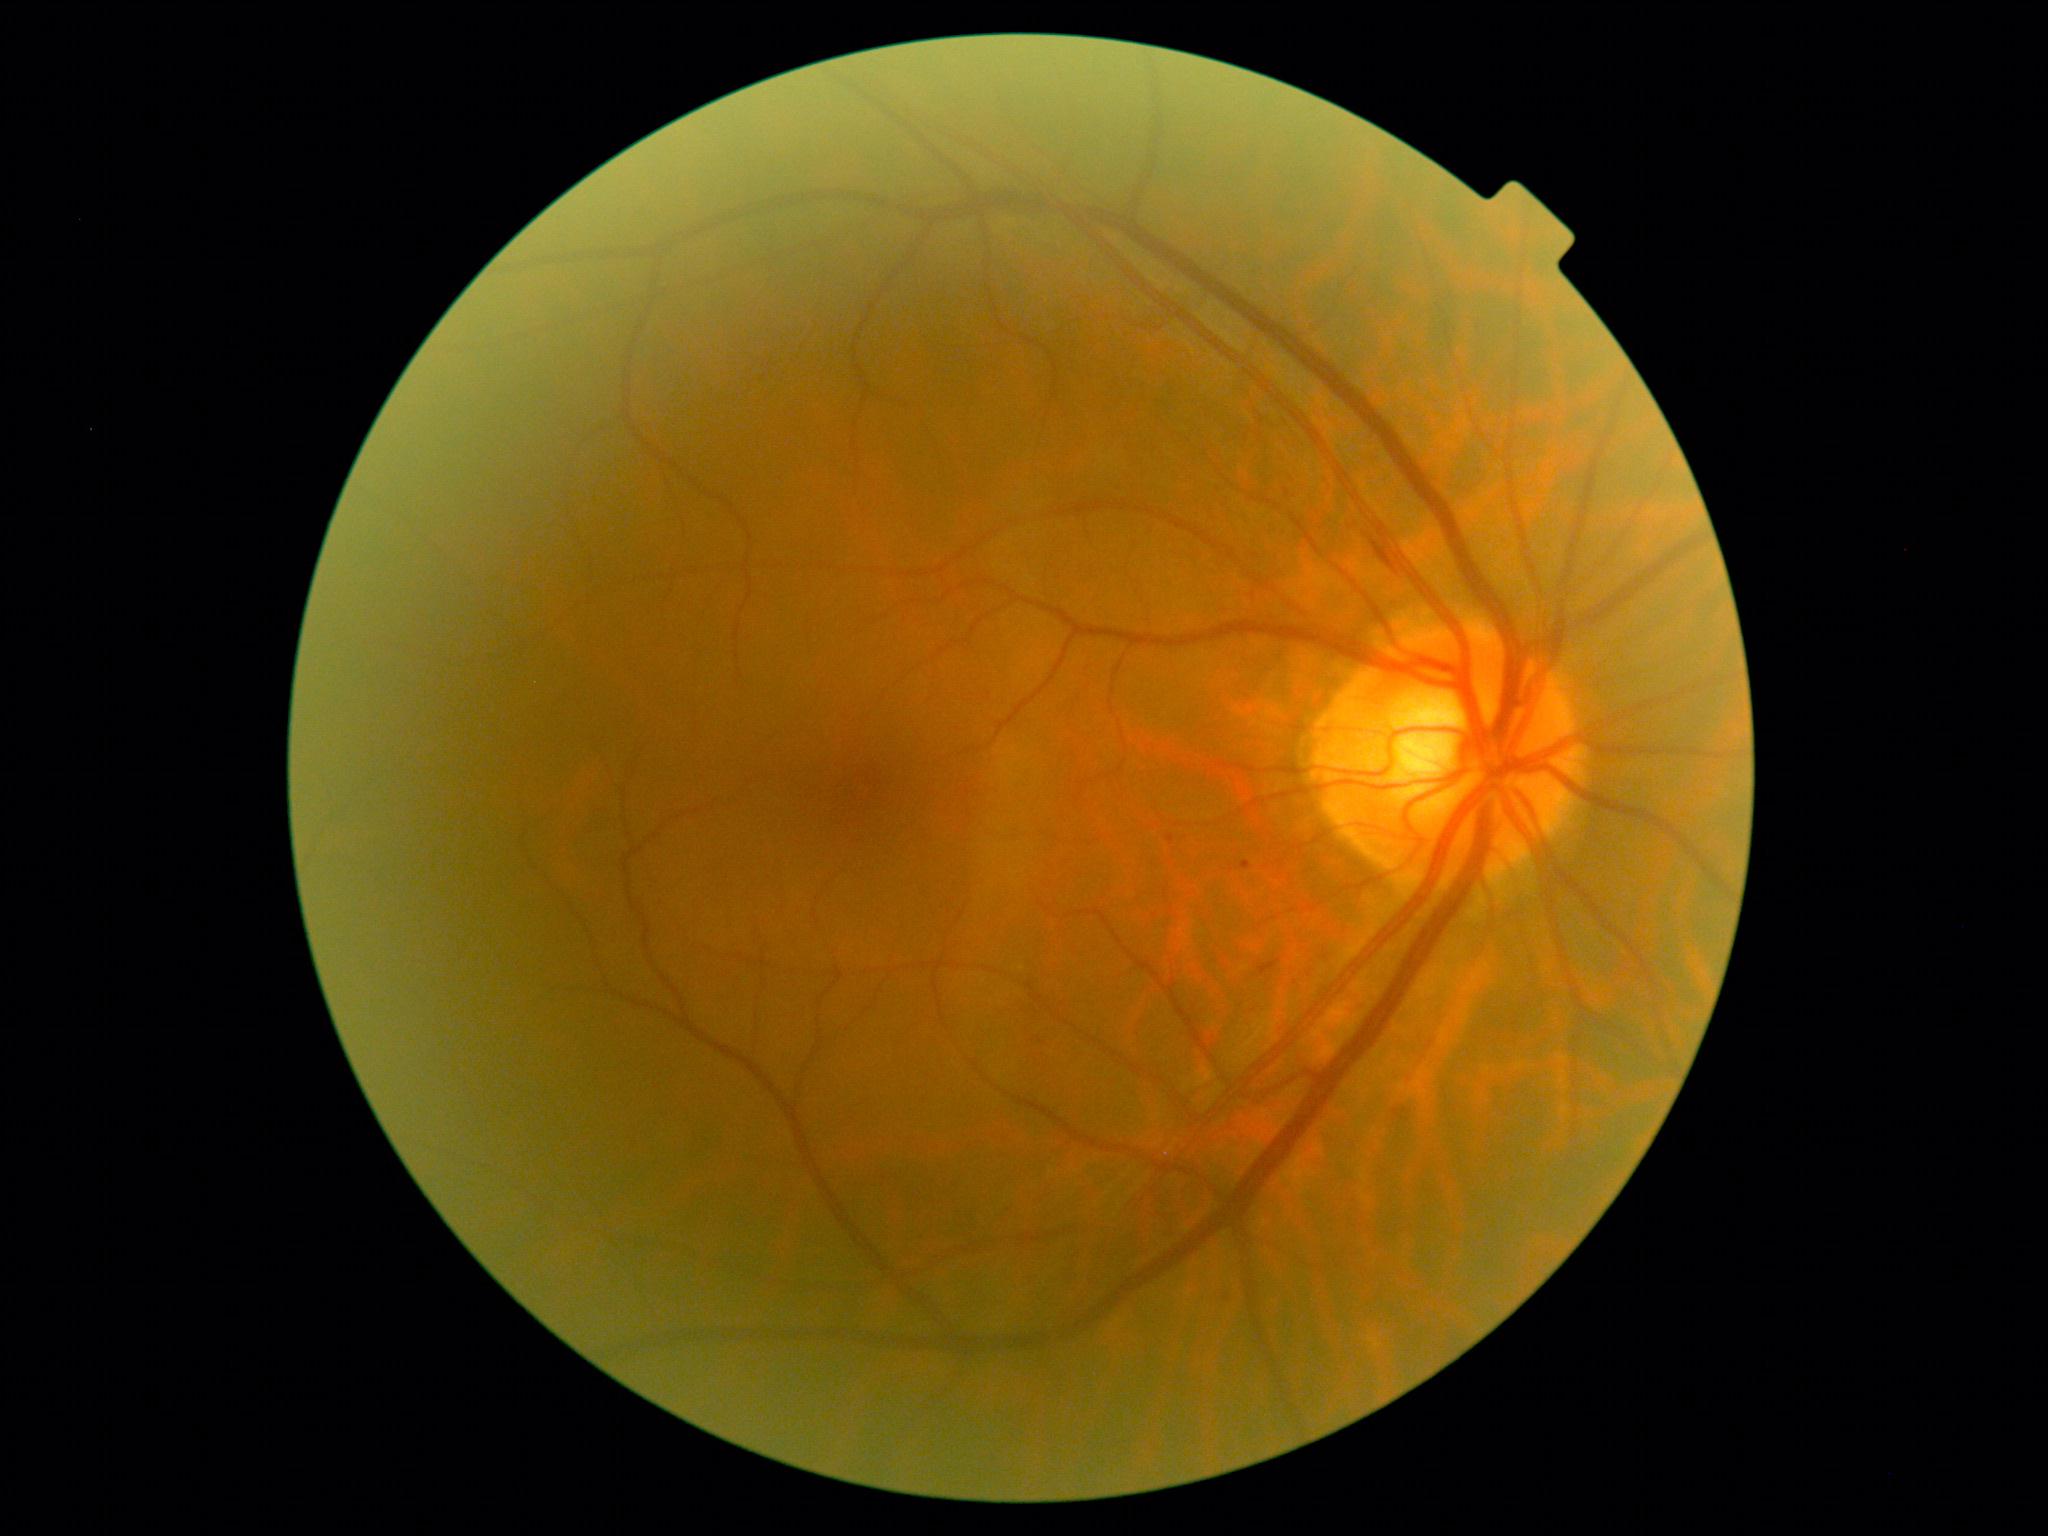

Diabetic retinopathy severity is grade 1.